45° FOV — 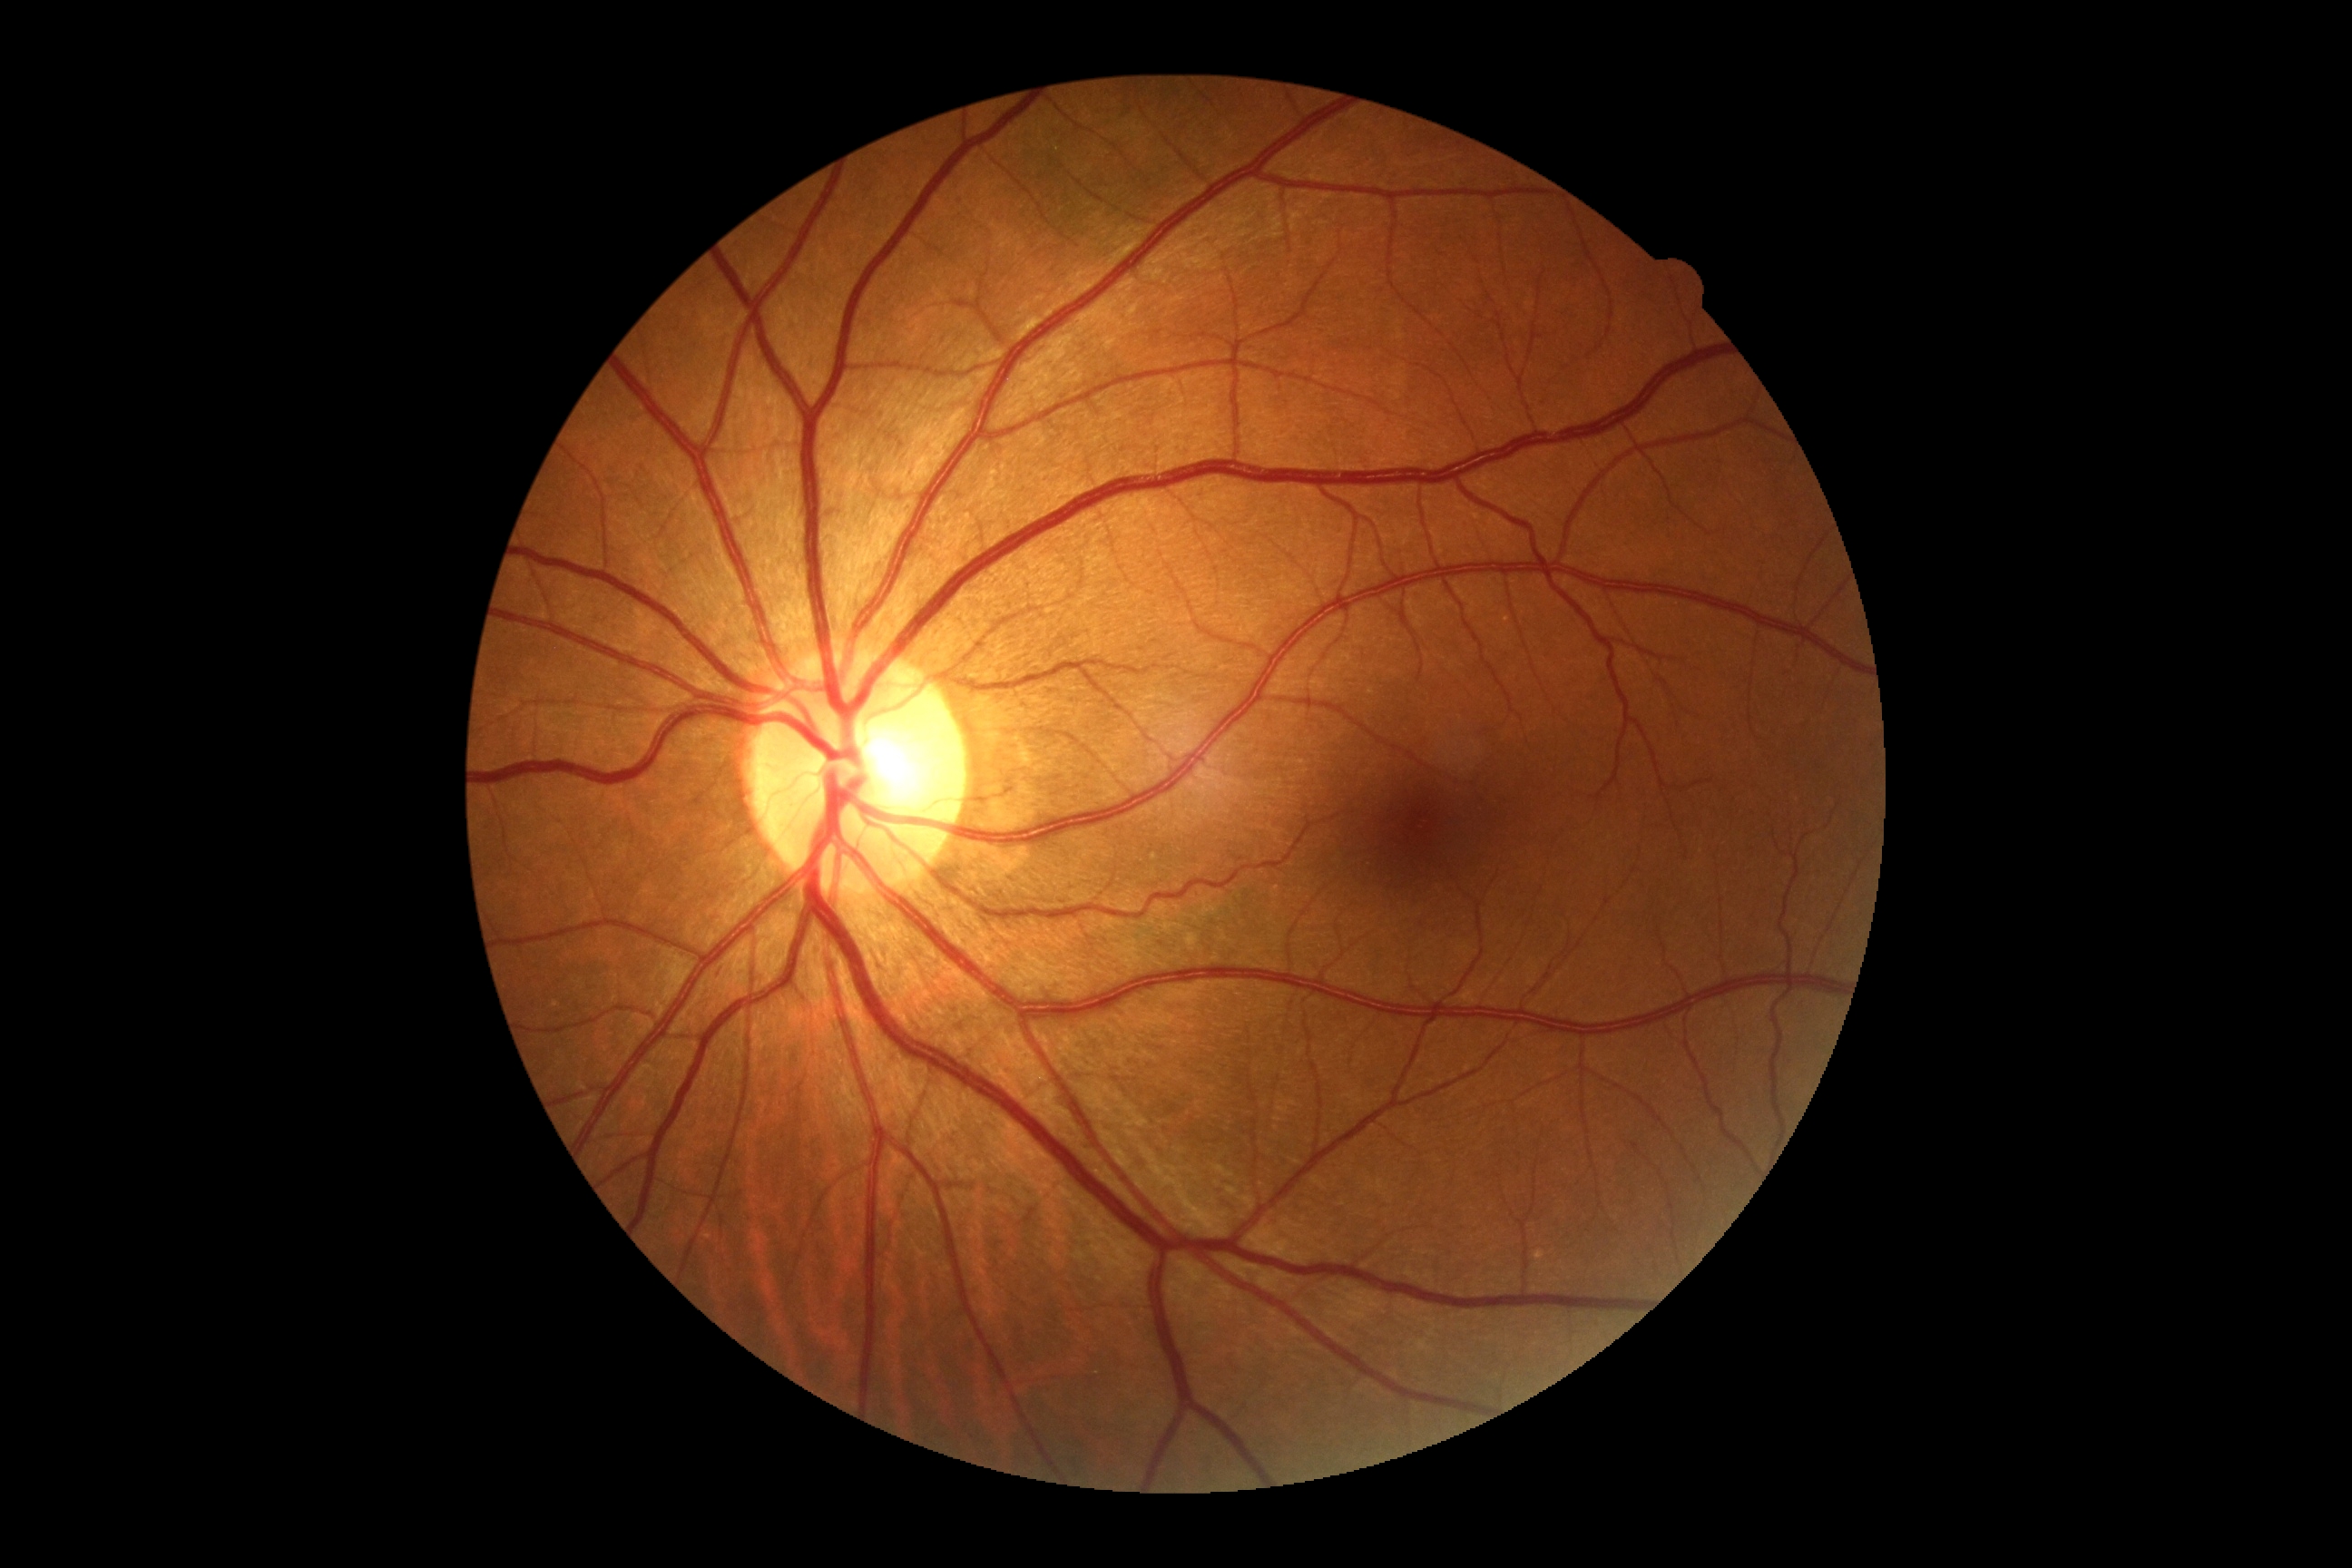
DR grade = 0 (no apparent retinopathy)